CFP: 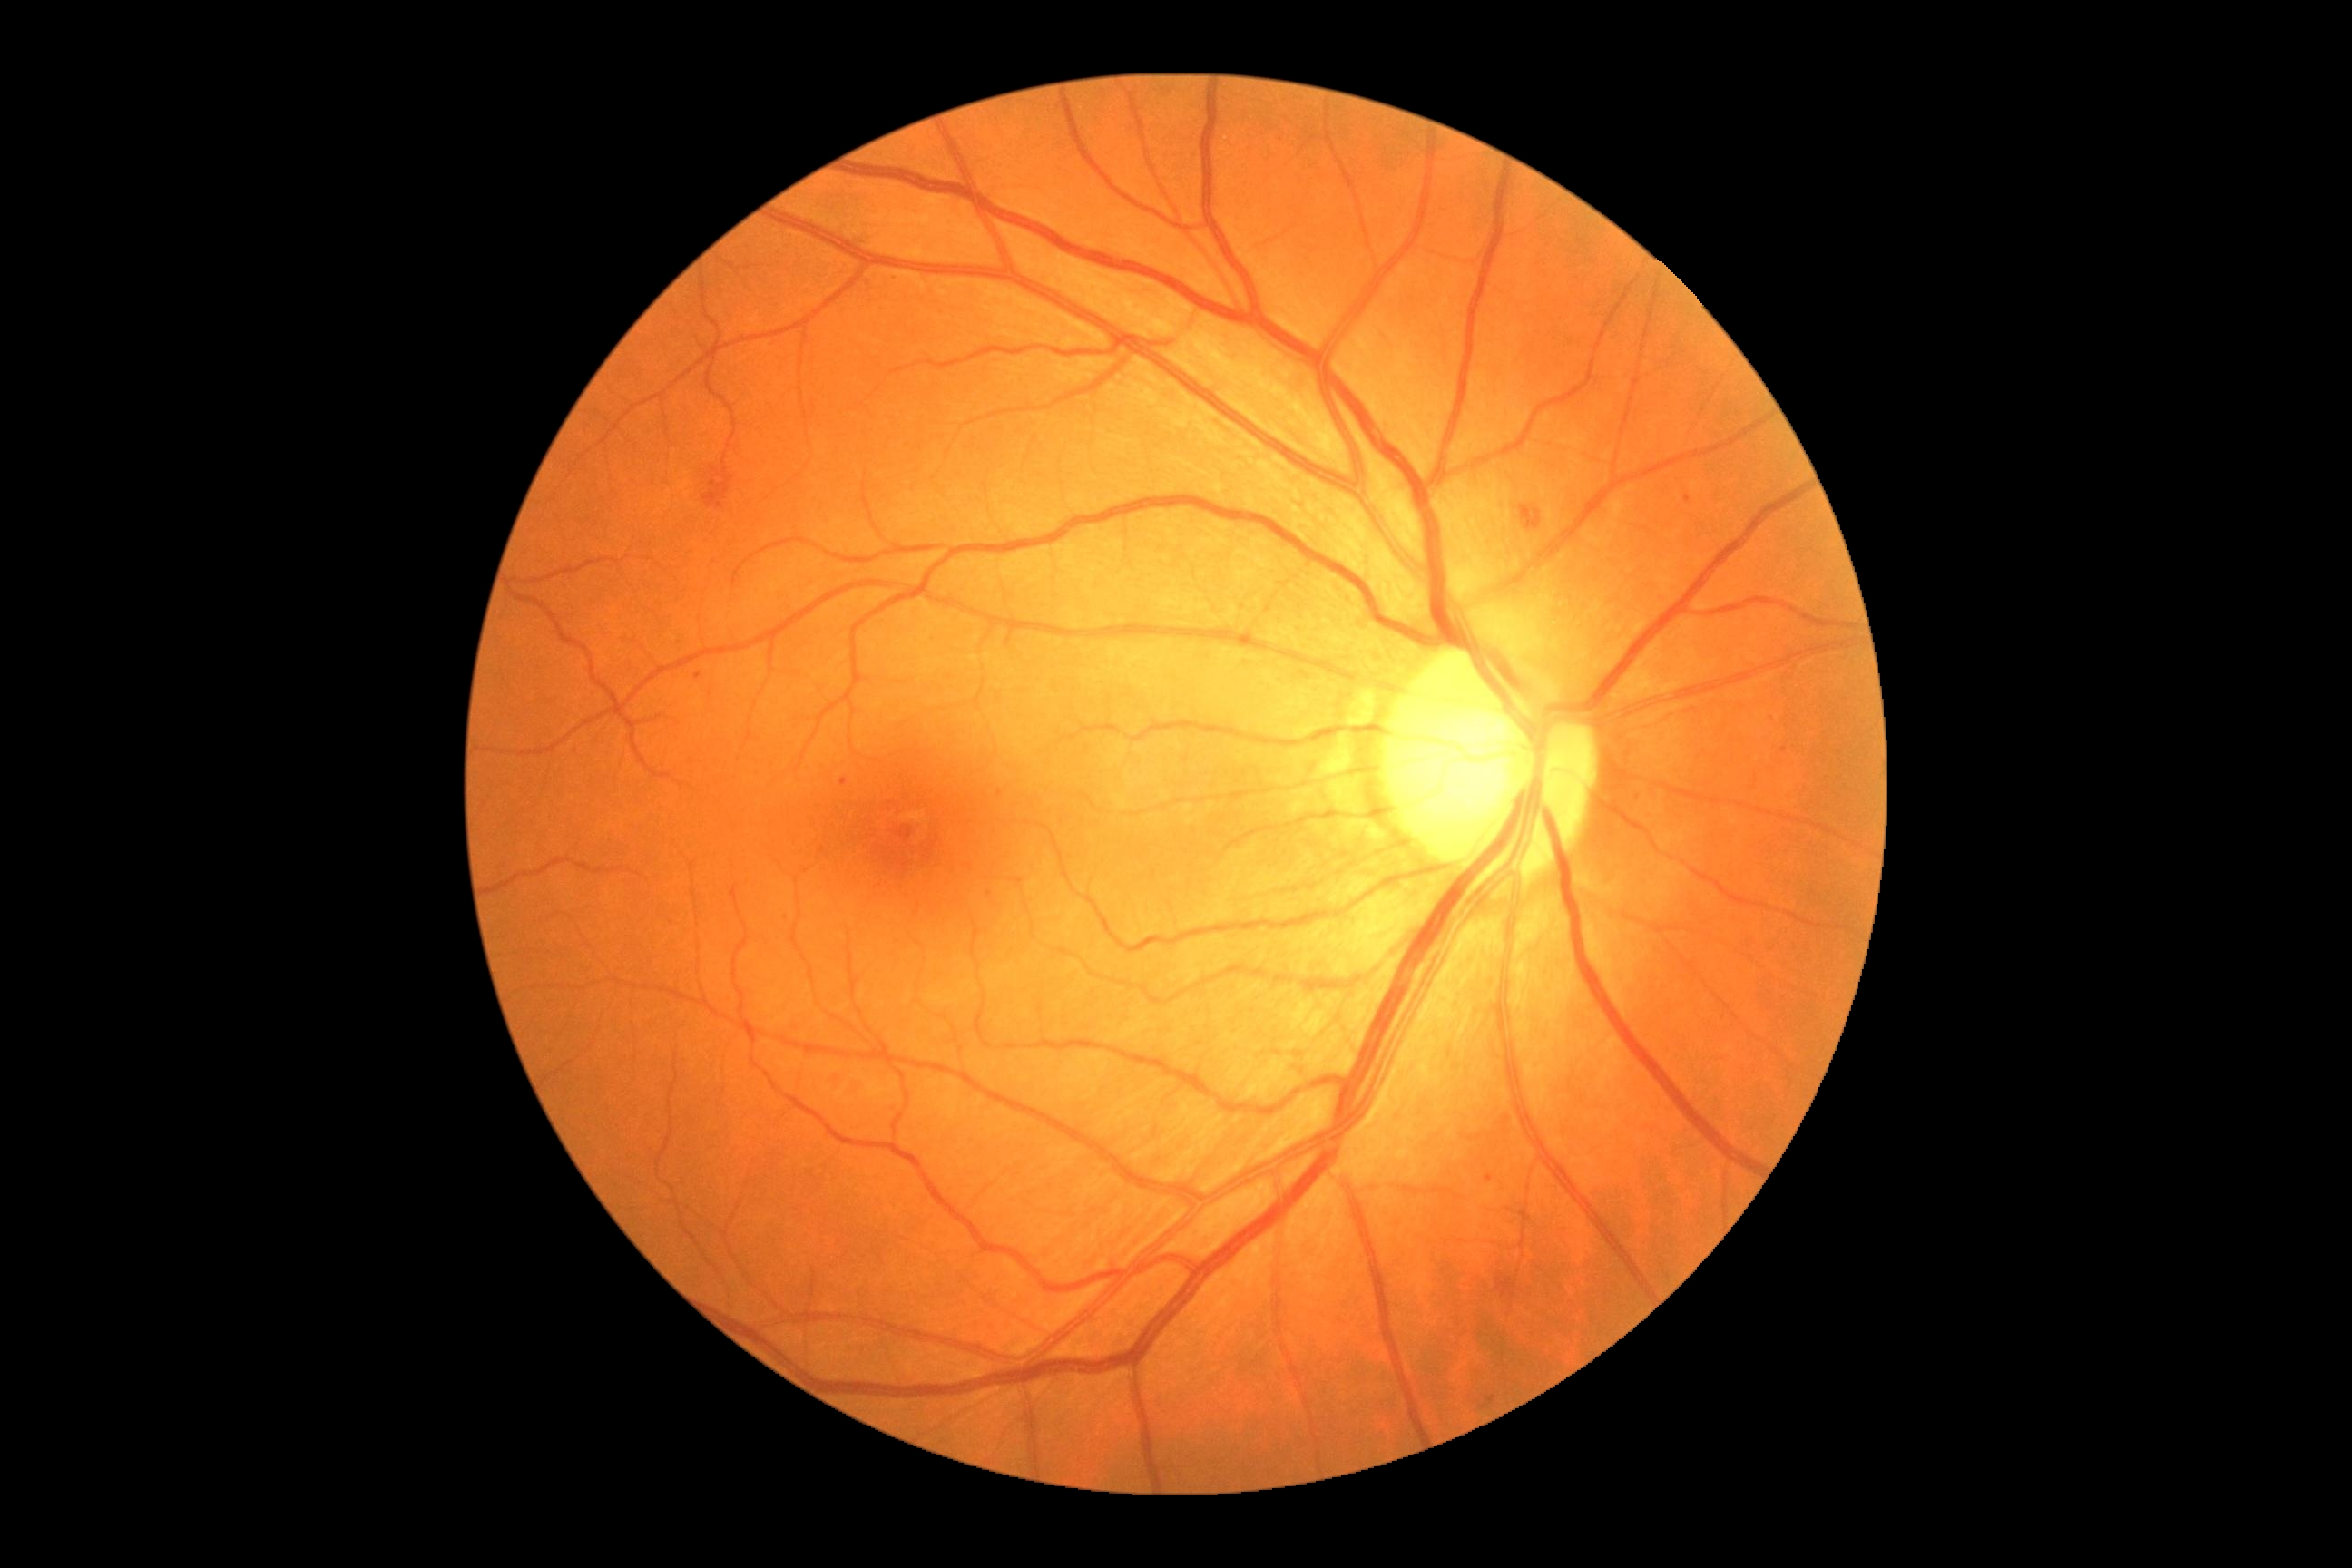 dr_grade: grade 2 — more than just microaneurysms but less than severe NPDR
dr_category: non-proliferative diabetic retinopathy